2352 by 1568 pixels · FOV: 45 degrees · color fundus image.
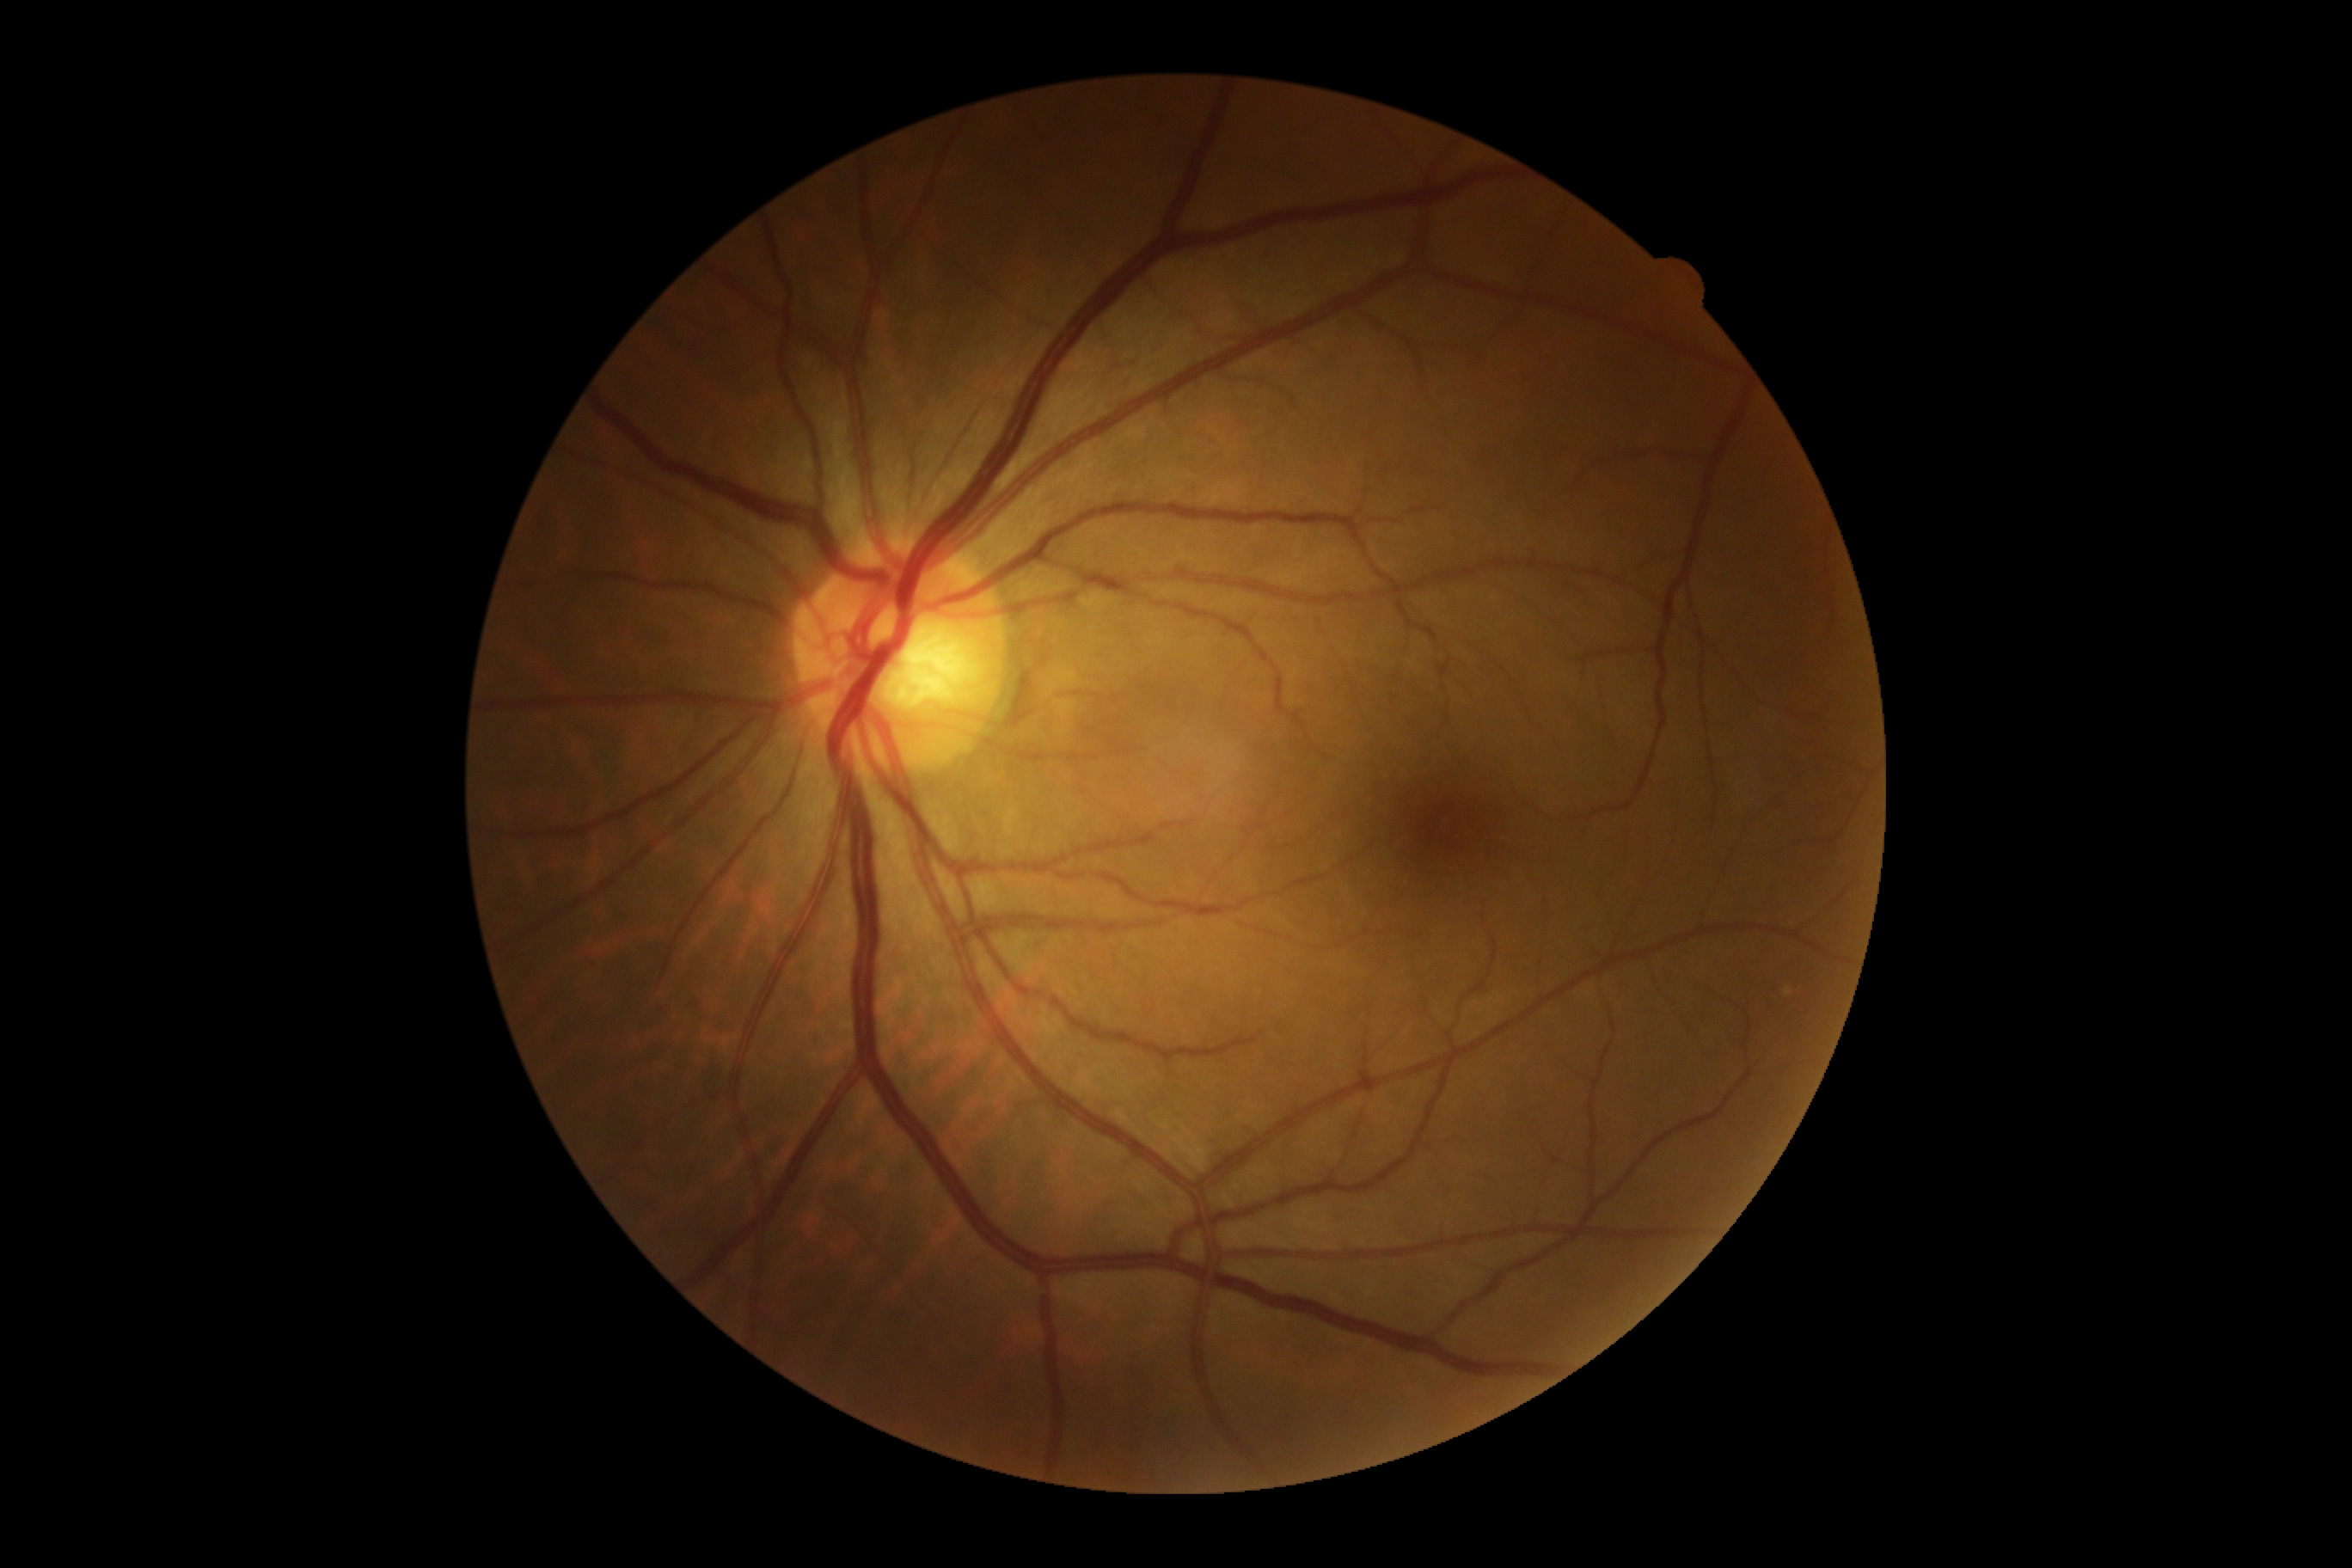 DR grade = 0.